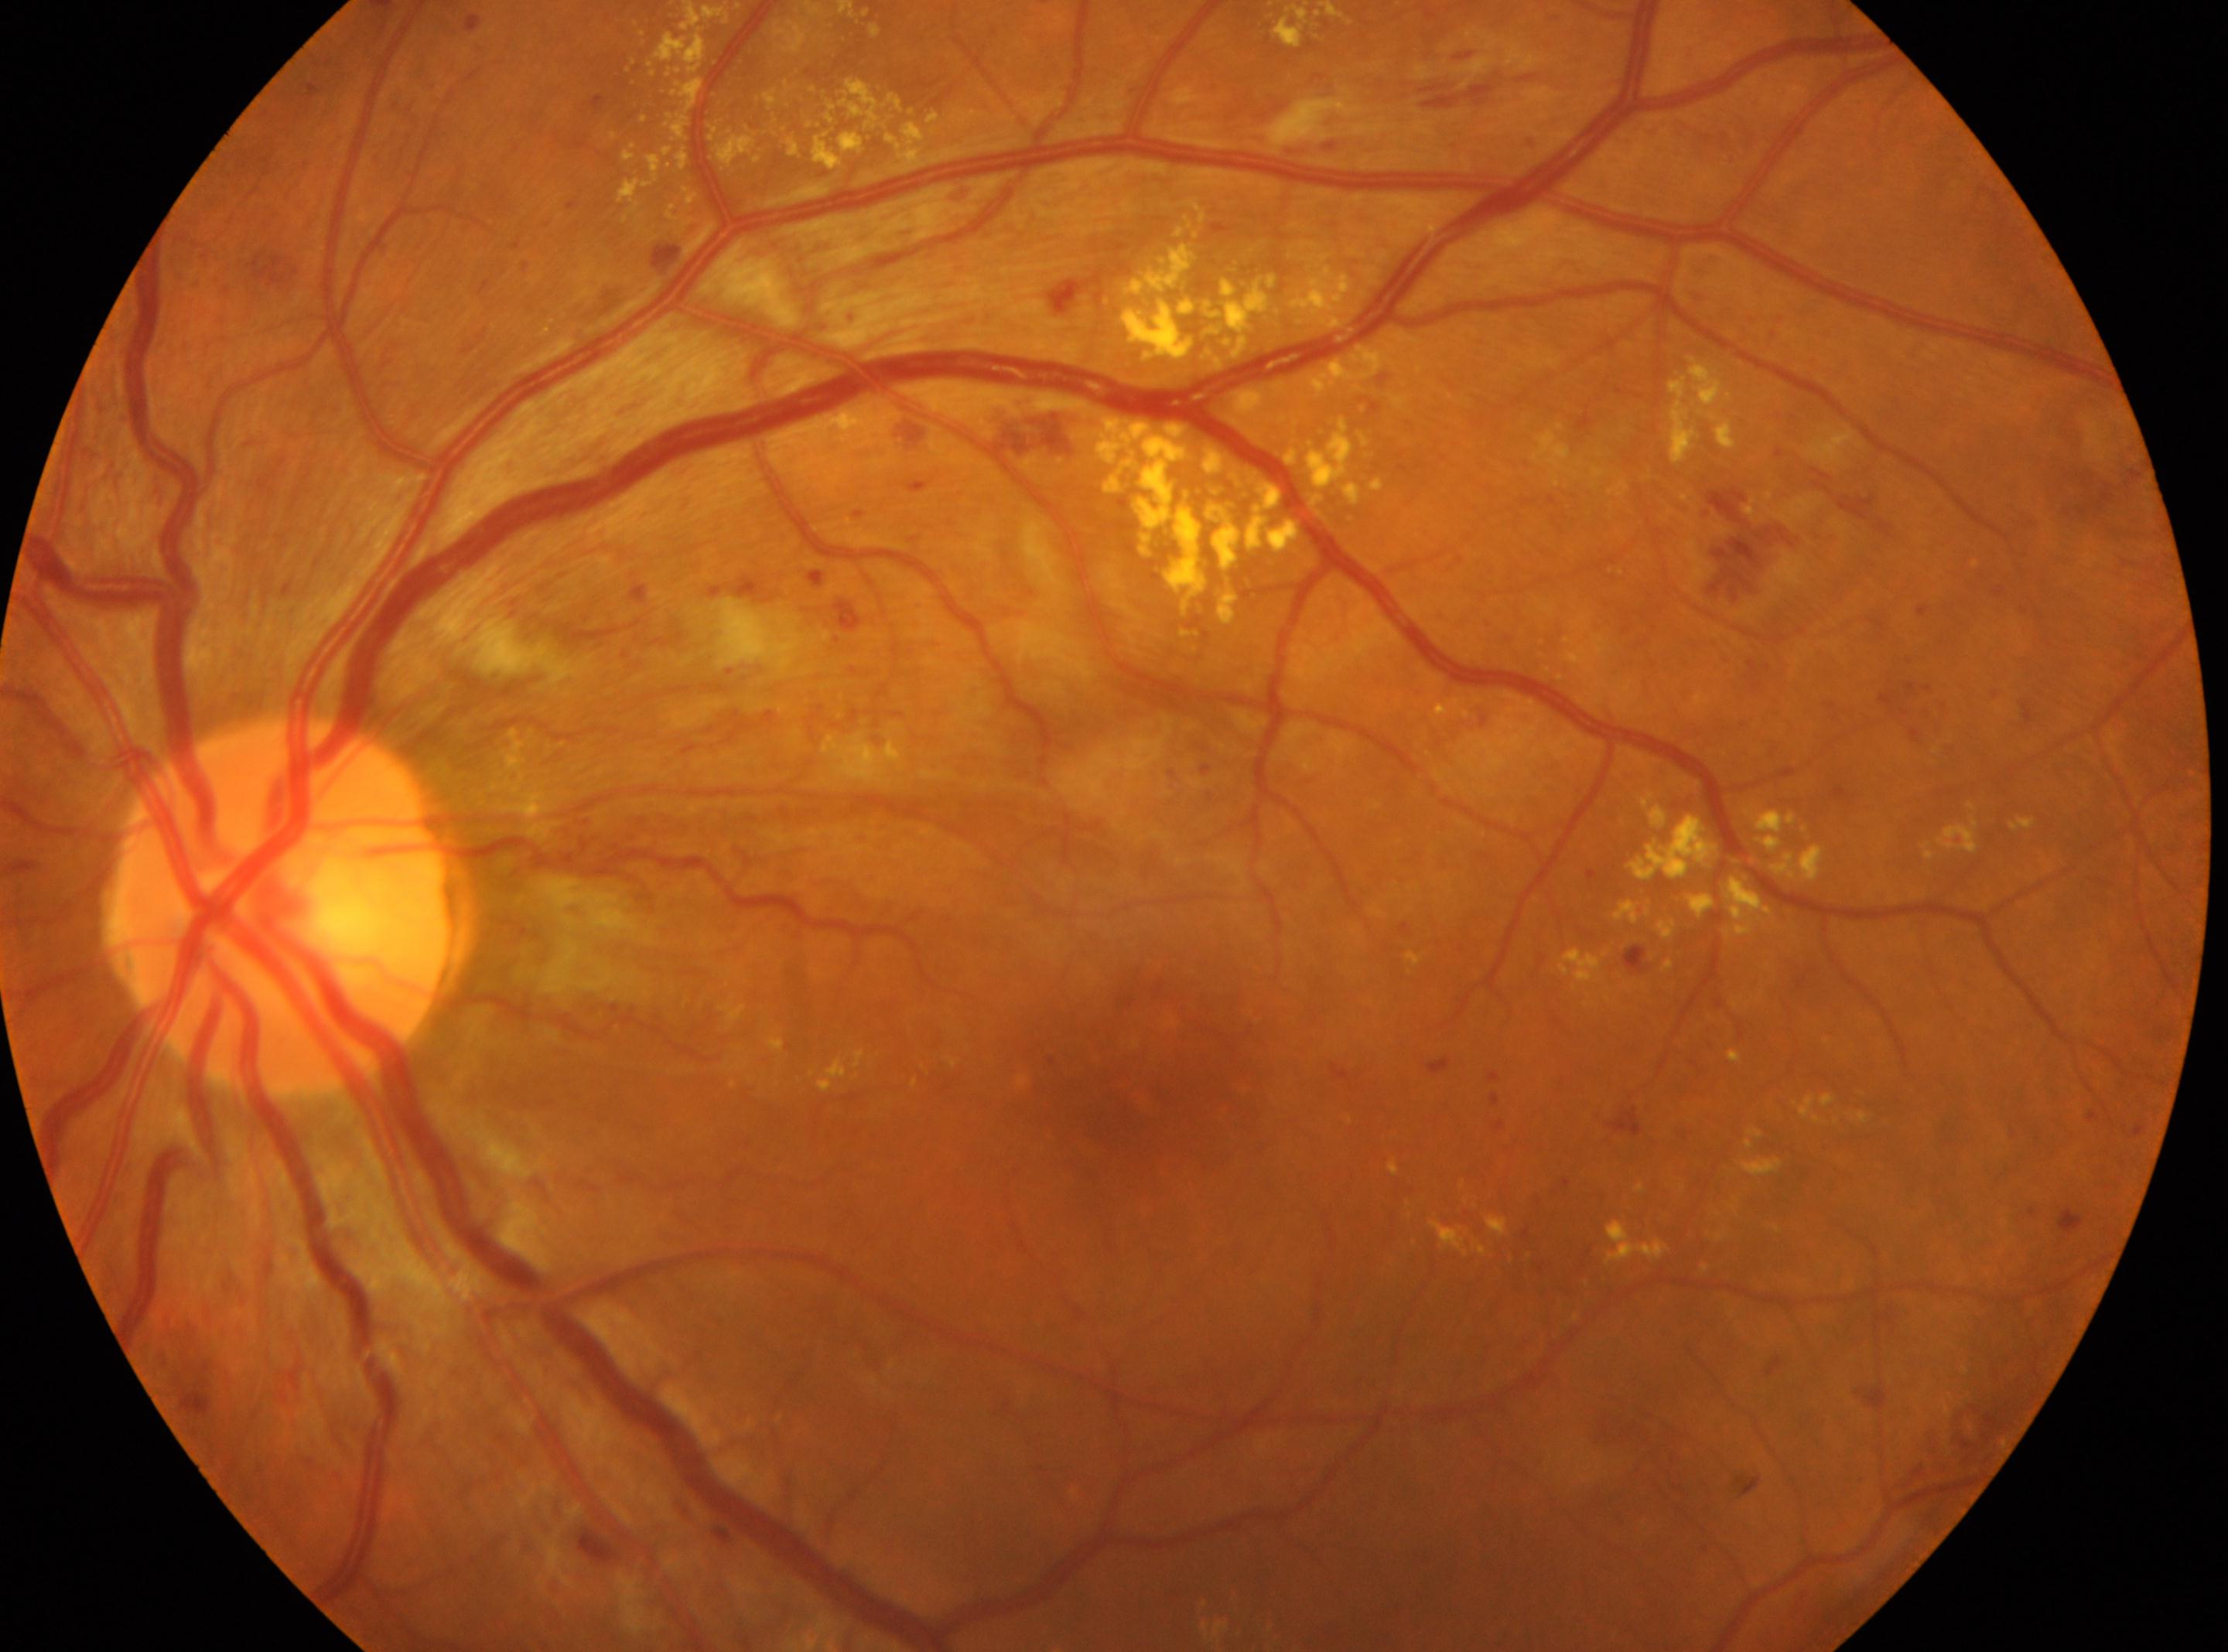 Optic disc: (277, 906).
This is the oculus sinister.
Retinopathy is 3/4.
Fovea center: (1114, 1097).